Graded on the modified Davis scale
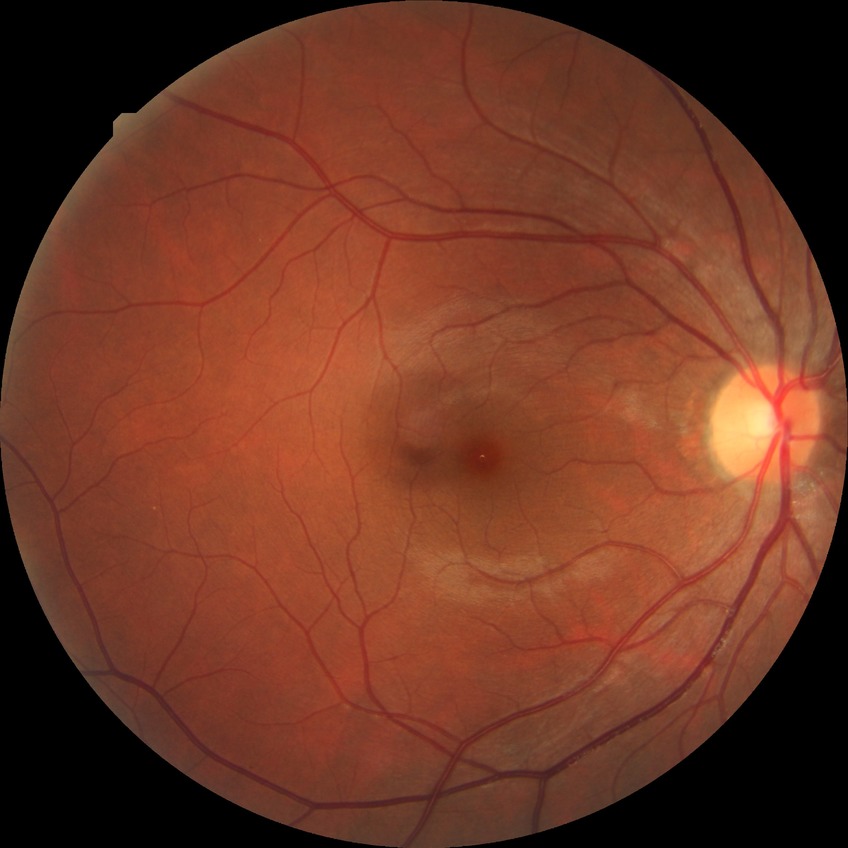
DR stage: NDR.